2352 x 1568 pixels · CFP: 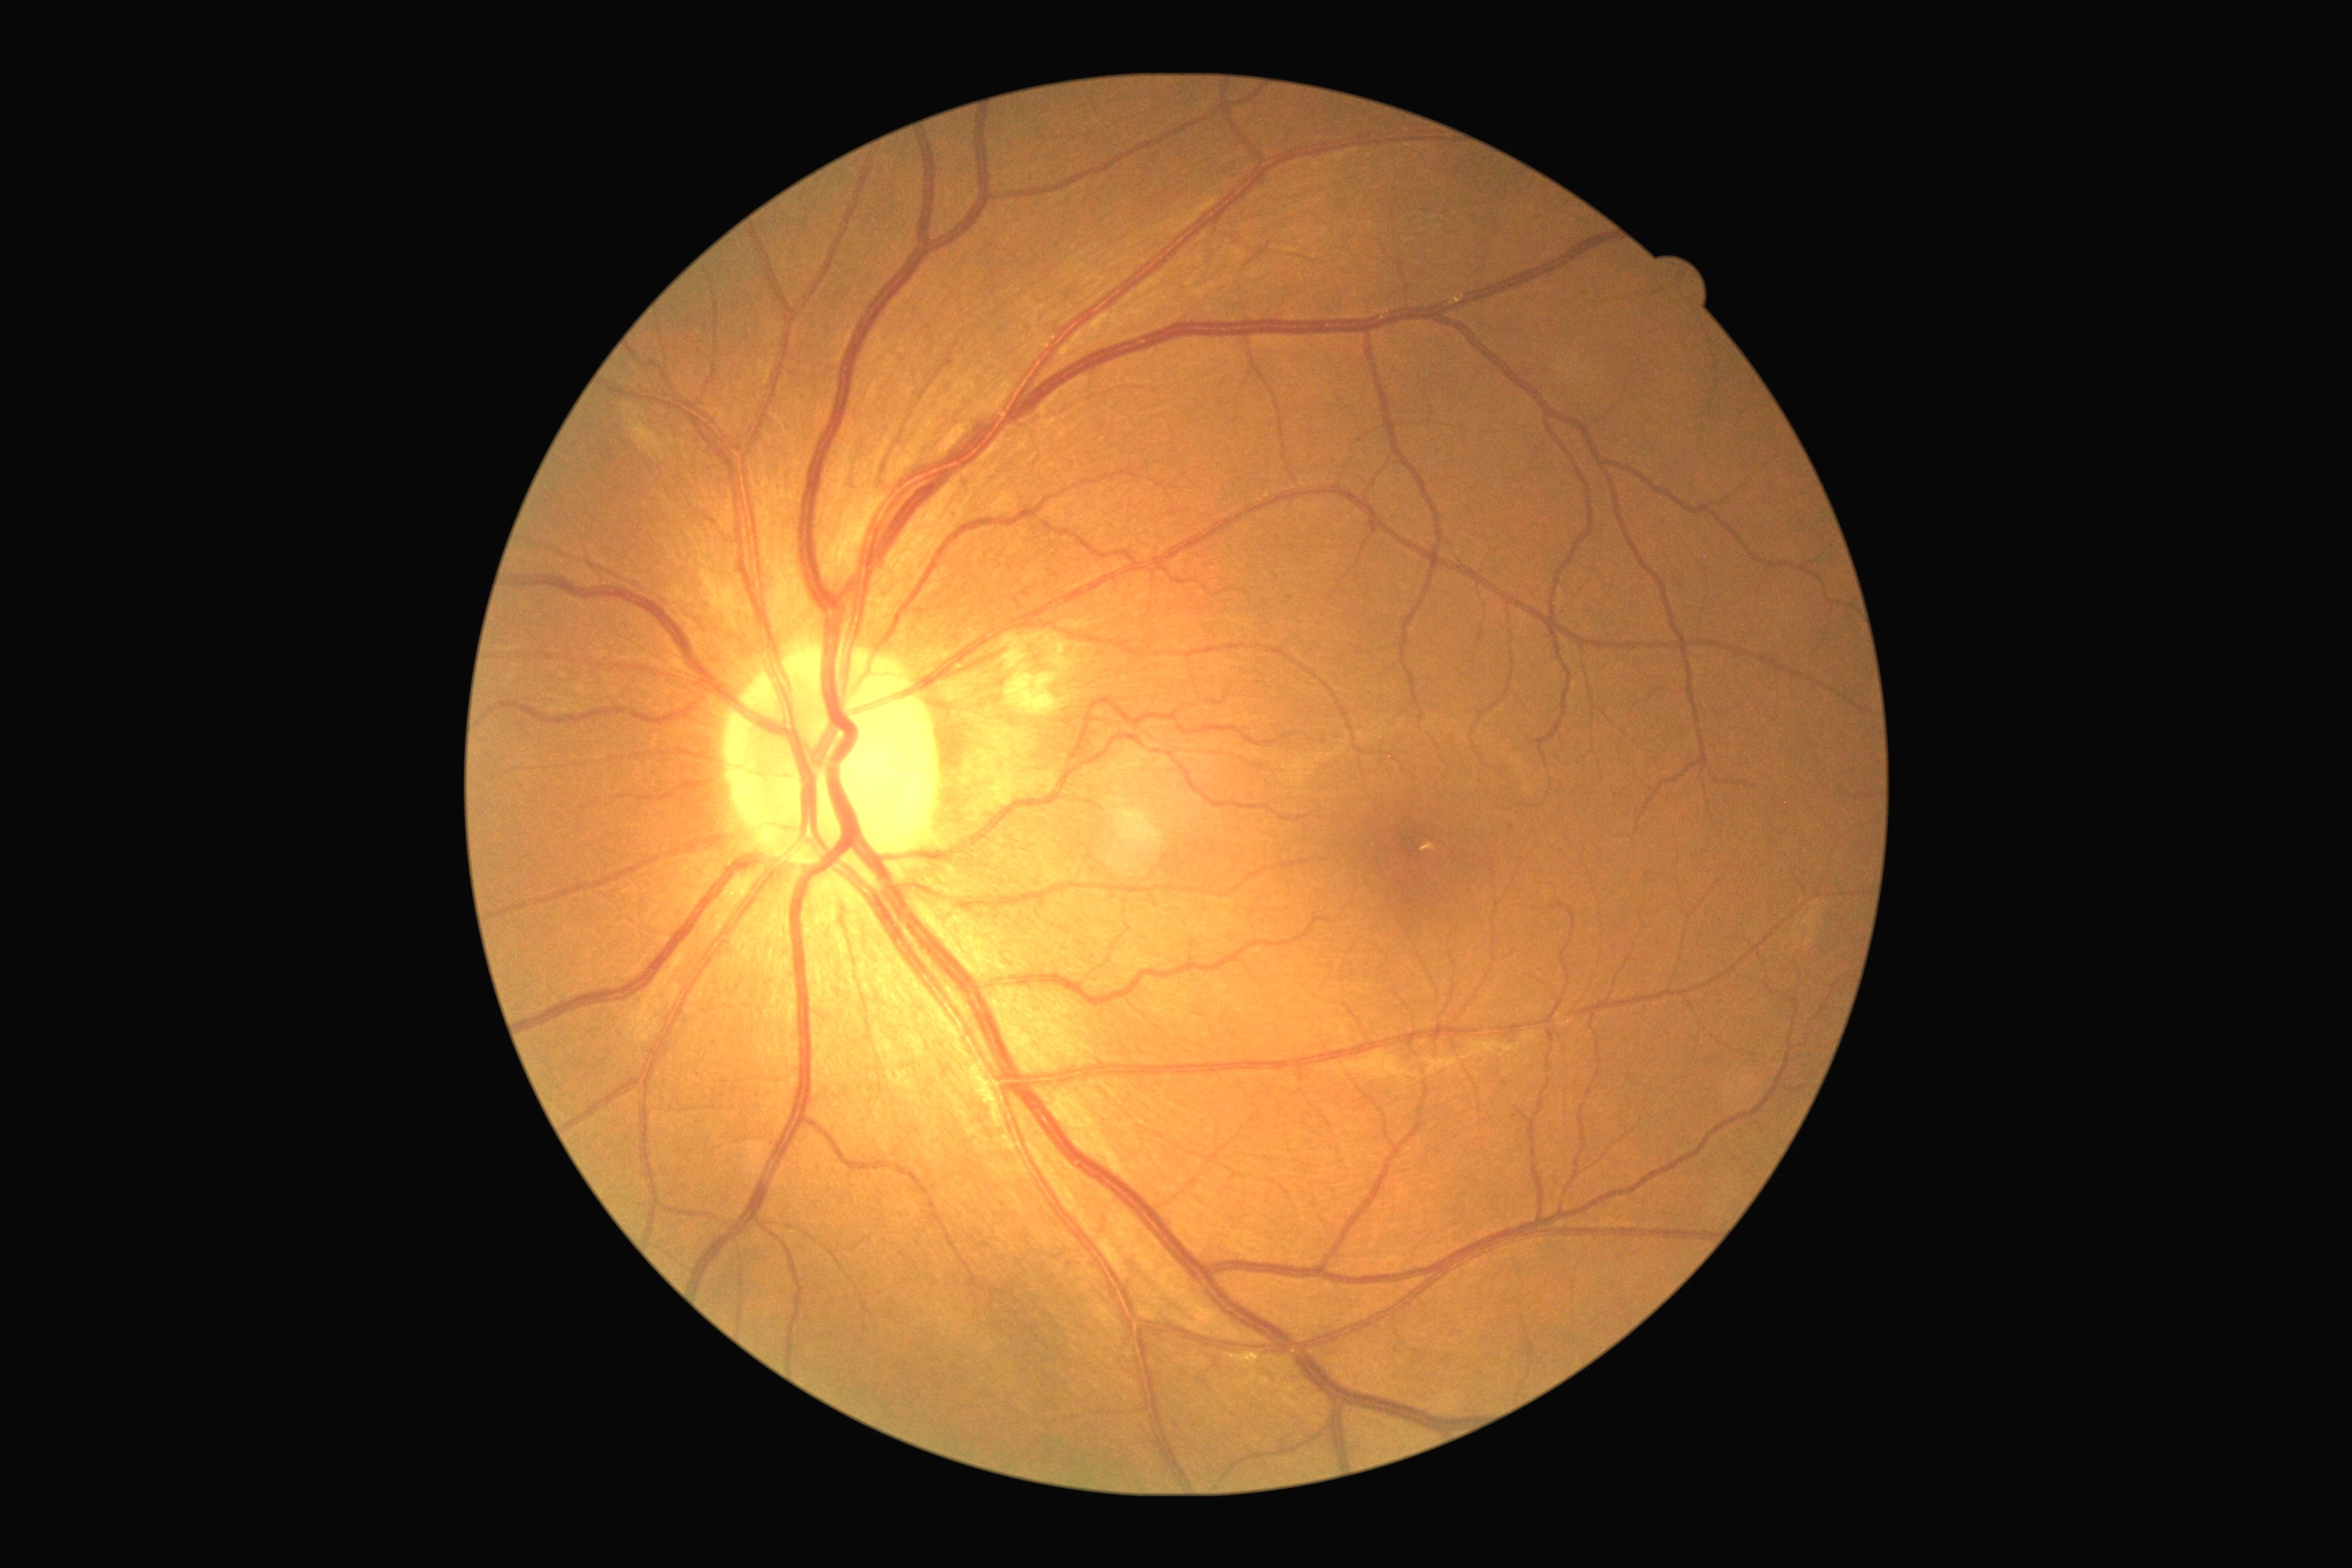

DR grade is 2 (moderate NPDR).